Infant wide-field fundus photograph · camera: Phoenix ICON (100° FOV)
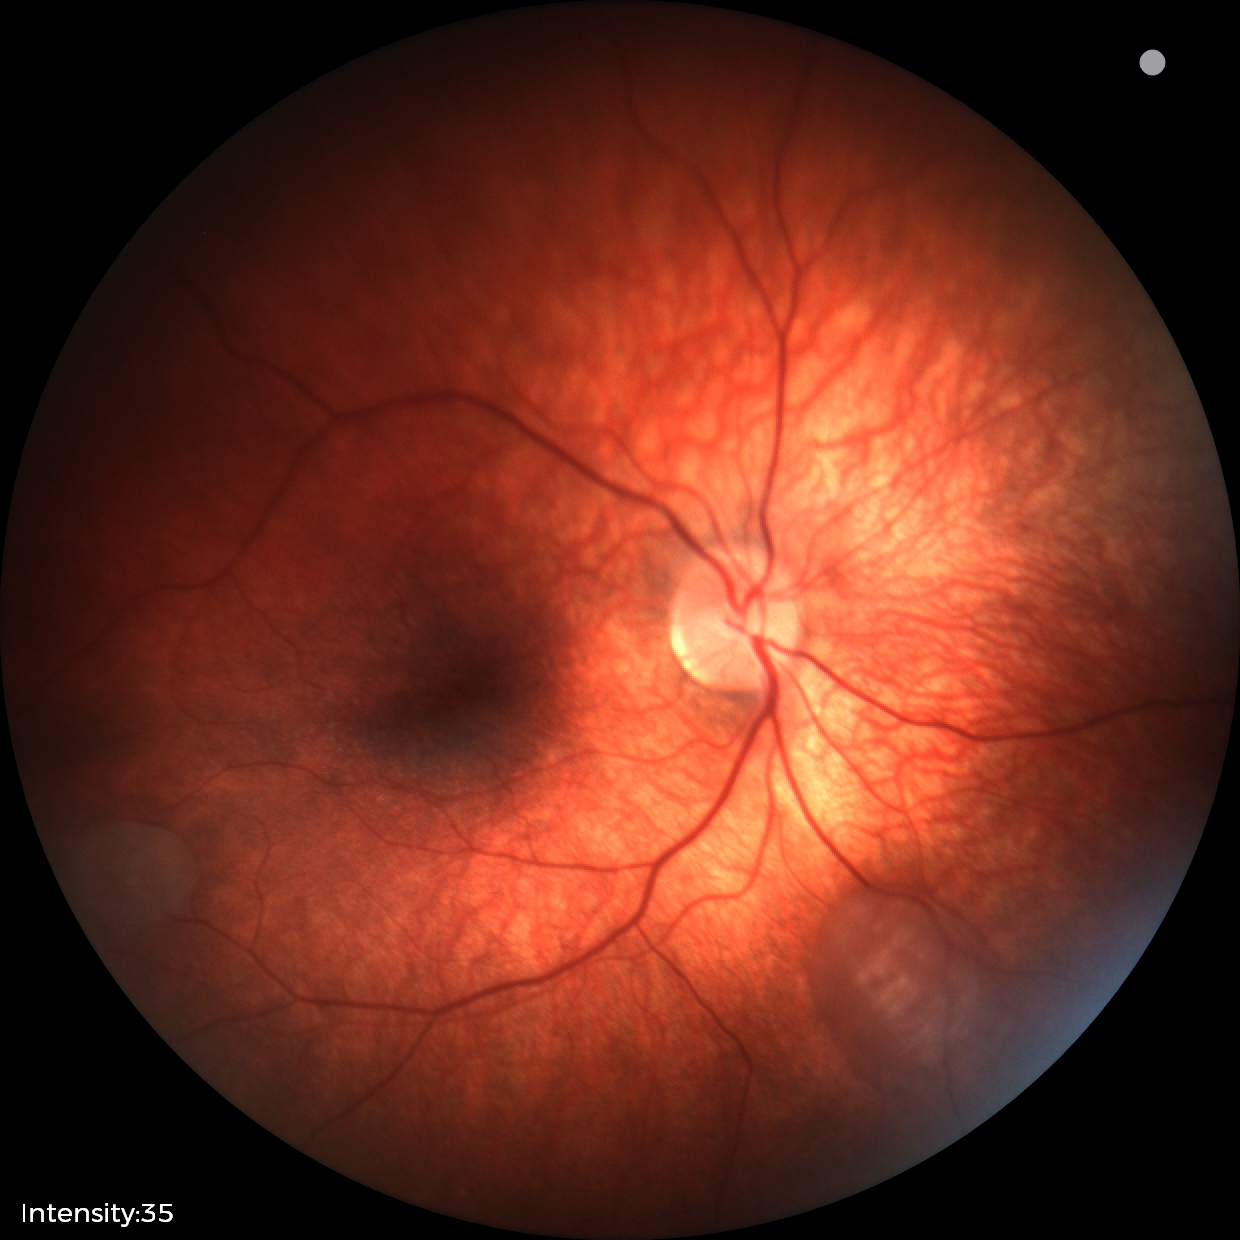

From an examination with diagnosis of retinal astrocytic hamartoma.